Captured without pupil dilation. 240x240
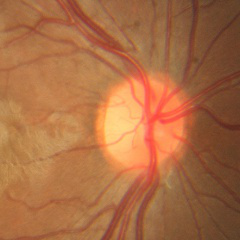 Glaucoma assessment: no signs of glaucoma.